Retinal fundus photograph.
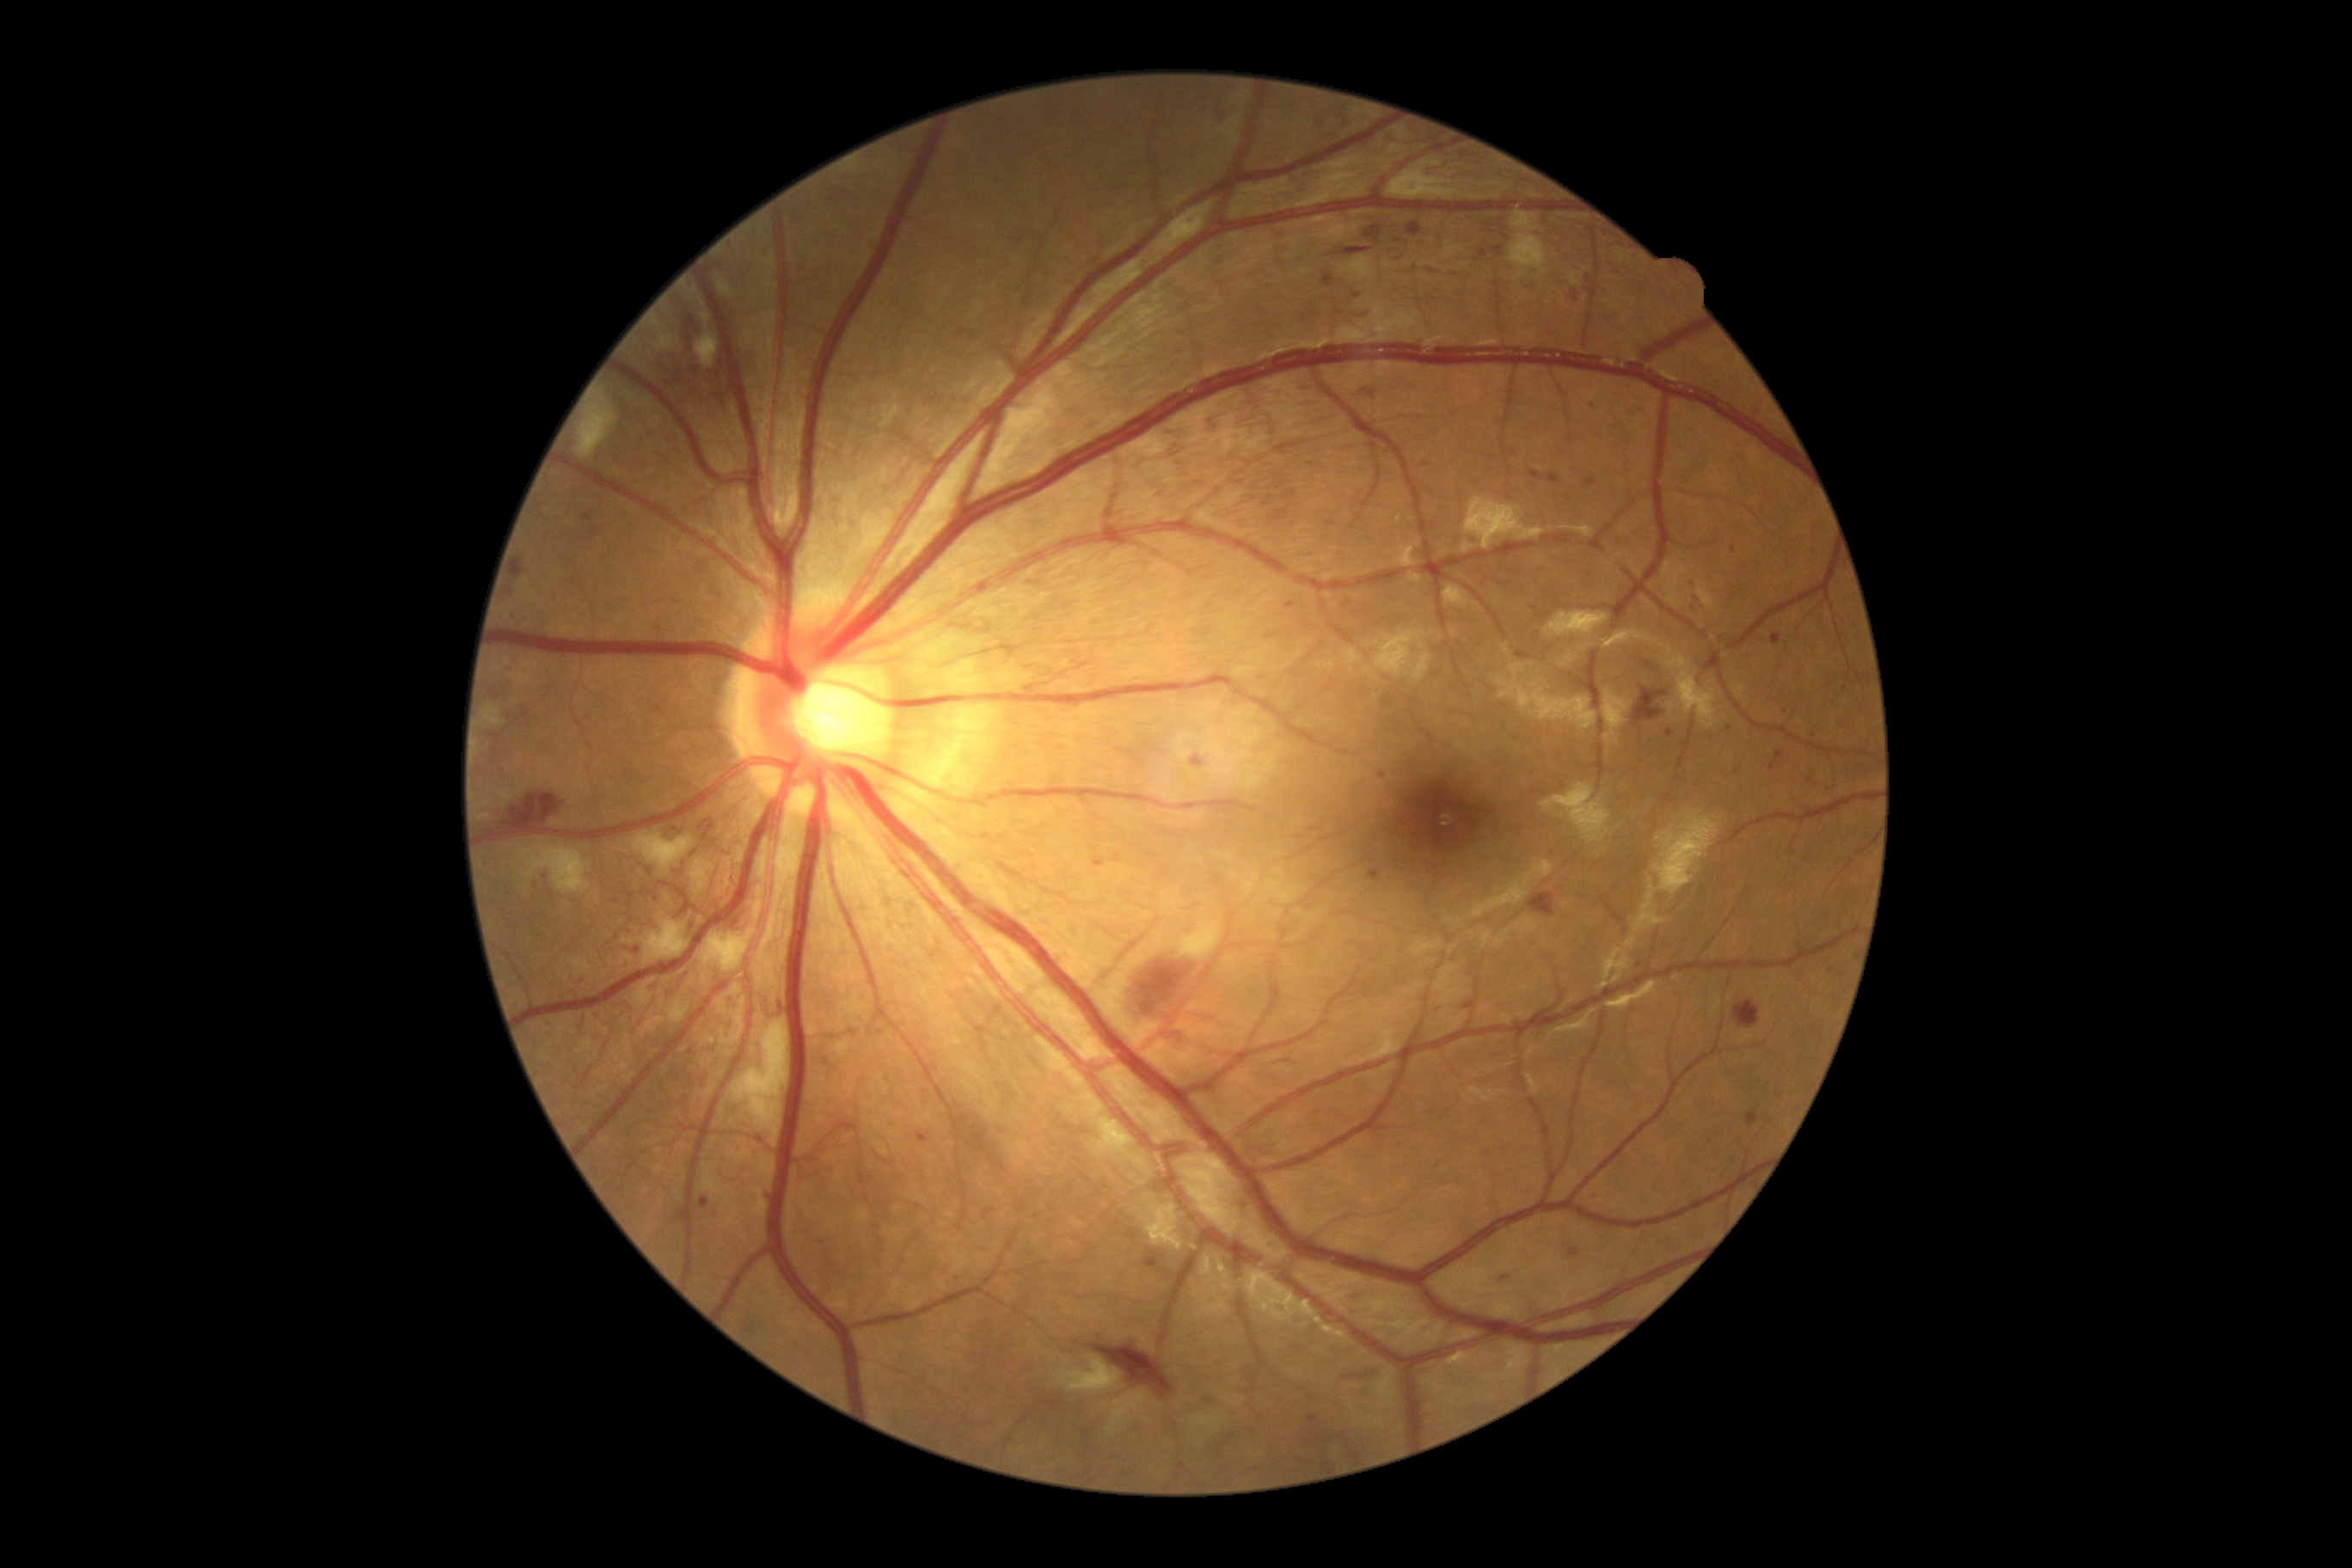

partial: true
dr_grade: 3
lesions:
  he:
    - {"left": 1146, "top": 1253, "right": 1160, "bottom": 1268}
    - {"left": 1584, "top": 479, "right": 1596, "bottom": 489}
    - {"left": 1328, "top": 522, "right": 1337, "bottom": 525}
    - {"left": 530, "top": 883, "right": 541, "bottom": 890}
    - {"left": 1583, "top": 276, "right": 1593, "bottom": 286}
    - {"left": 757, "top": 245, "right": 771, "bottom": 255}
    - {"left": 1120, "top": 948, "right": 1199, "bottom": 1038}
    - {"left": 1528, "top": 893, "right": 1557, "bottom": 917}
    - {"left": 1179, "top": 902, "right": 1210, "bottom": 914}
    - {"left": 582, "top": 513, "right": 592, "bottom": 522}
    - {"left": 1393, "top": 252, "right": 1402, "bottom": 262}
    - {"left": 802, "top": 273, "right": 821, "bottom": 283}
    - {"left": 1302, "top": 458, "right": 1318, "bottom": 470}
    - {"left": 1297, "top": 400, "right": 1323, "bottom": 410}
    - {"left": 1321, "top": 276, "right": 1335, "bottom": 288}
  he_small_centers:
    - (x=1640, y=966)
    - (x=1383, y=776)
    - (x=1340, y=313)
    - (x=618, y=937)
  se:
    - {"left": 720, "top": 998, "right": 747, "bottom": 1046}
    - {"left": 1387, "top": 157, "right": 1459, "bottom": 200}
    - {"left": 632, "top": 979, "right": 656, "bottom": 1008}
    - {"left": 730, "top": 984, "right": 742, "bottom": 996}
    - {"left": 1055, "top": 1356, "right": 1122, "bottom": 1395}
    - {"left": 699, "top": 929, "right": 756, "bottom": 974}
    - {"left": 484, "top": 707, "right": 505, "bottom": 726}
    - {"left": 654, "top": 321, "right": 663, "bottom": 328}
    - {"left": 1172, "top": 917, "right": 1222, "bottom": 960}
    - {"left": 718, "top": 278, "right": 733, "bottom": 298}
    - {"left": 518, "top": 847, "right": 592, "bottom": 897}